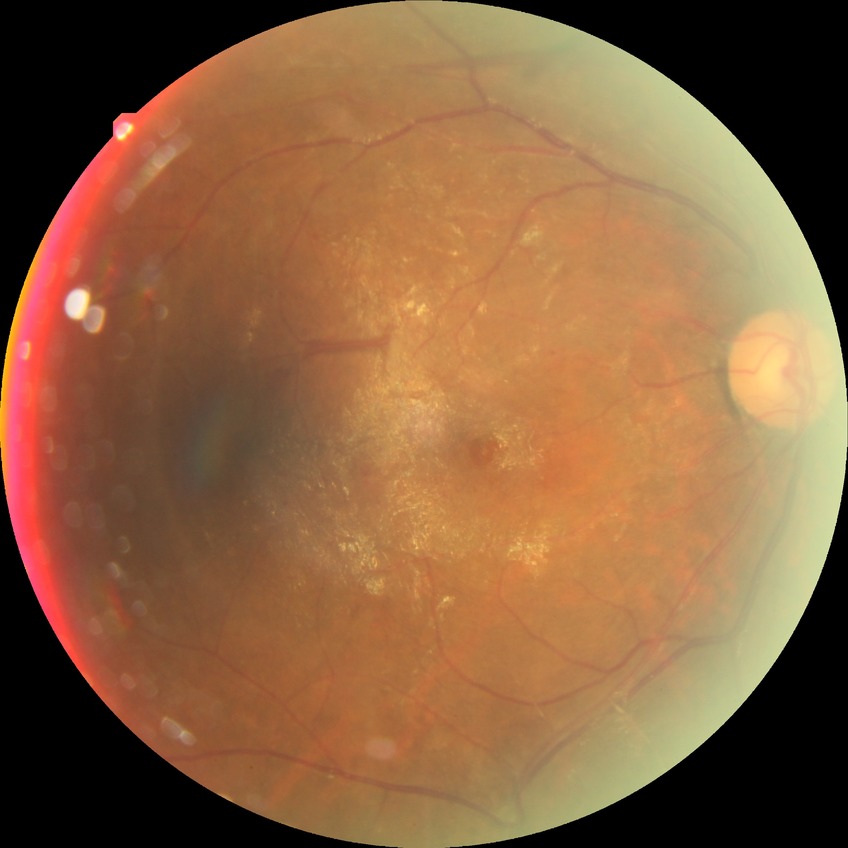

diabetic retinopathy (DR)@proliferative diabetic retinopathy (PDR).